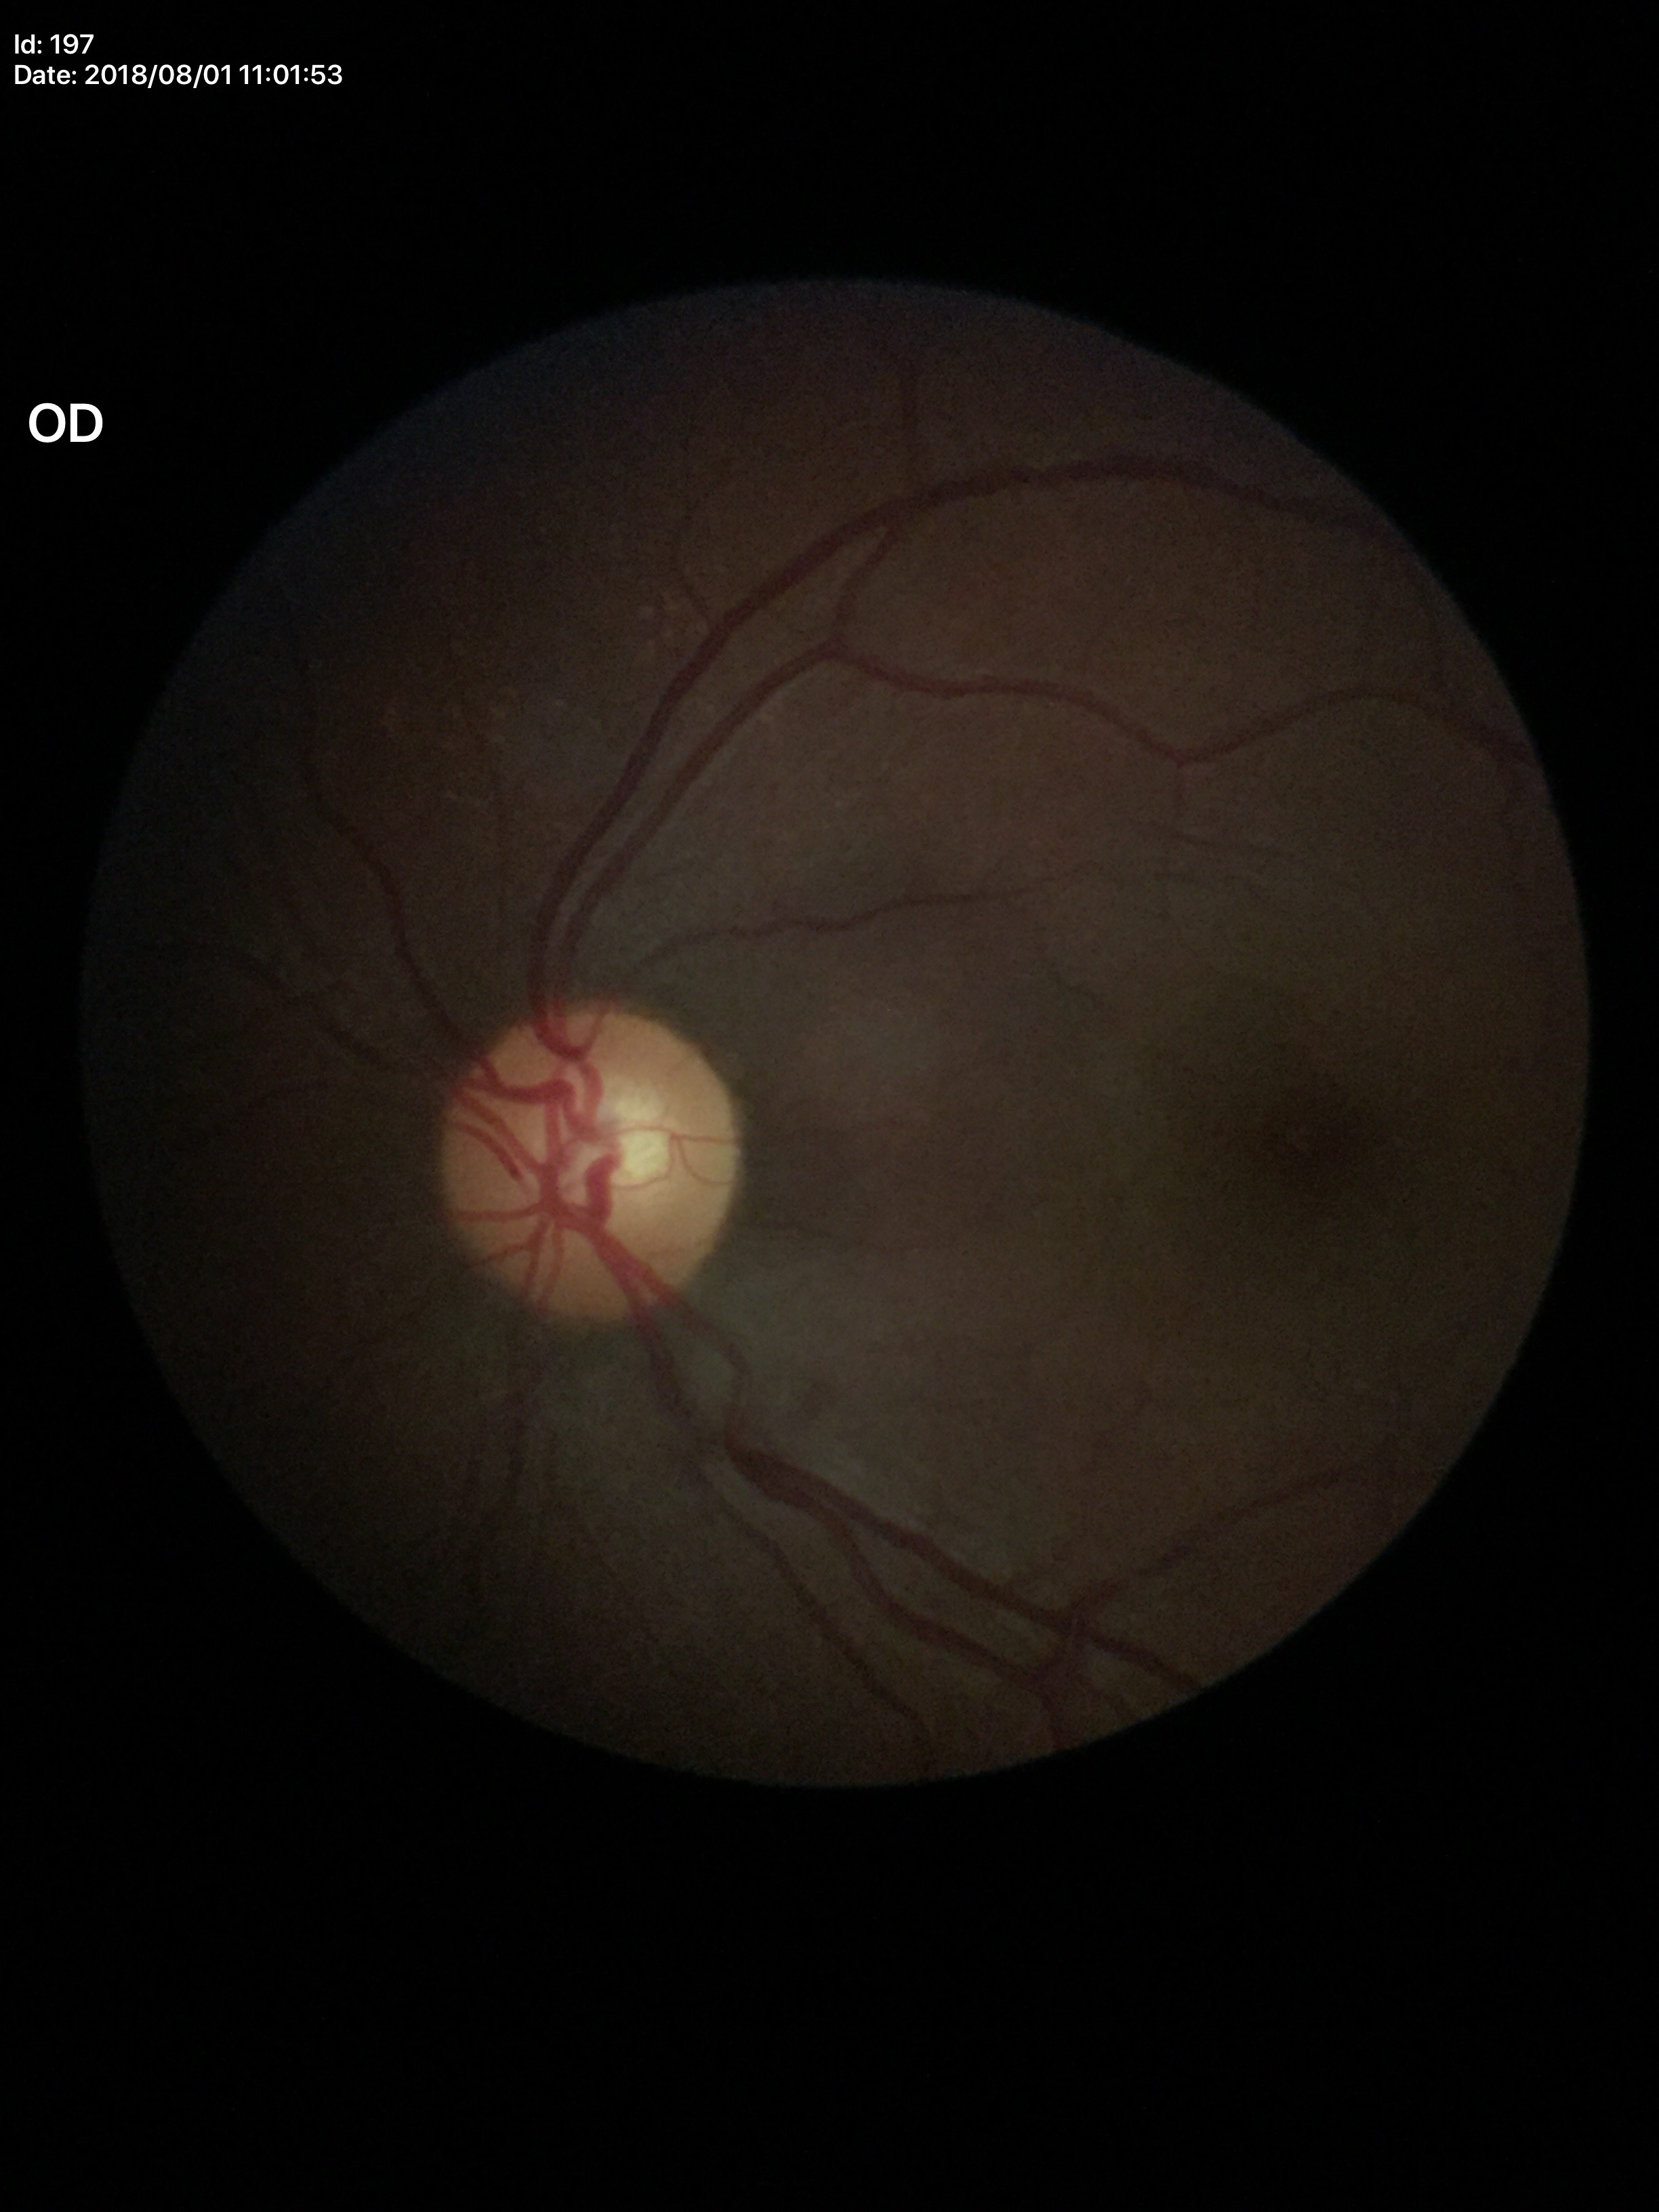
Q: What is the glaucoma assessment?
A: no suspicious findings
Q: Vertical CDR?
A: 0.51
Q: Area CDR?
A: 0.28